45° field of view · CFP.
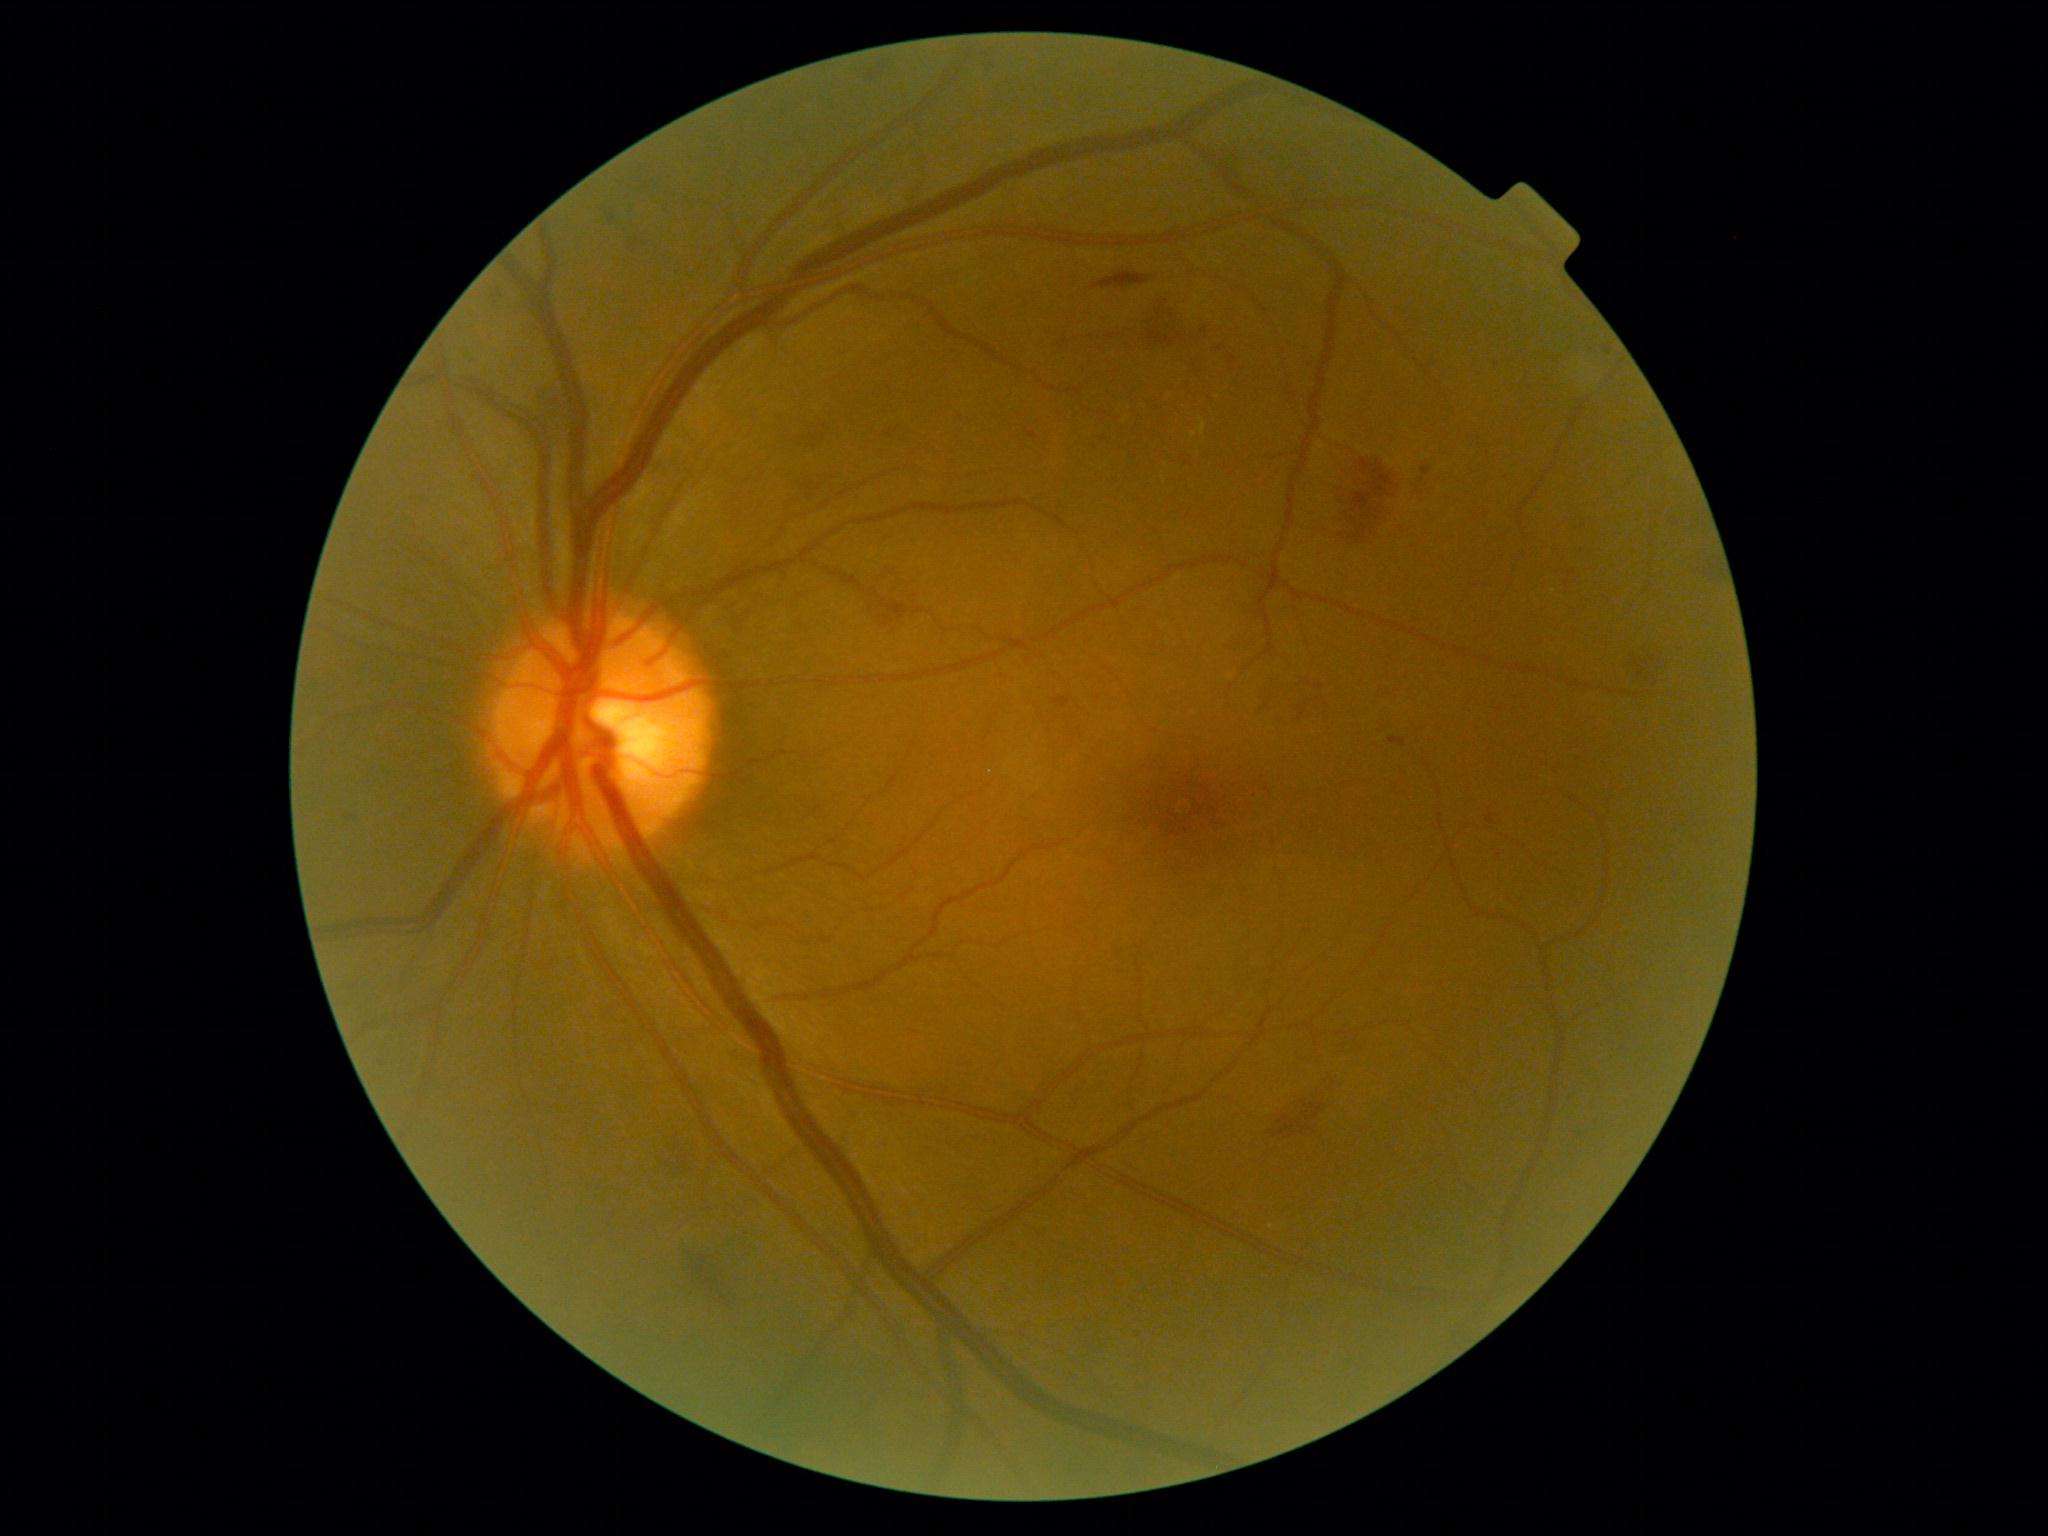 <lesions partial="true">
  <dr_grade>2</dr_grade>
  <se />
  <ex>x1=1200, y1=418, x2=1207, y2=435</ex>
  <ex_small>1194, 435</ex_small>
  <ma>x1=1216, y1=346, x2=1224, y2=352; x1=980, y1=57, x2=989, y2=65; x1=346, y1=816, x2=354, y2=822; x1=1026, y1=429, x2=1039, y2=441; x1=1388, y1=738, x2=1407, y2=748; x1=1605, y1=346, x2=1613, y2=356; x1=1315, y1=684, x2=1325, y2=691; x1=1486, y1=810, x2=1497, y2=826; x1=1201, y1=327, x2=1208, y2=336; x1=1053, y1=698, x2=1070, y2=708; x1=1420, y1=467, x2=1432, y2=483; x1=1569, y1=570, x2=1577, y2=578</ma>
  <ma_small>1497, 365; 1585, 526; 1140, 1336</ma_small>
  <he partial="true">x1=1297, y1=700, x2=1310, y2=721; x1=868, y1=62, x2=888, y2=82; x1=1417, y1=481, x2=1438, y2=500; x1=796, y1=483, x2=832, y2=503; x1=538, y1=386, x2=575, y2=450; x1=1065, y1=293, x2=1213, y2=386; x1=683, y1=1247, x2=742, y2=1317; x1=490, y1=284, x2=509, y2=307; x1=1624, y1=652, x2=1668, y2=681; x1=666, y1=1146, x2=691, y2=1181; x1=733, y1=616, x2=746, y2=631; x1=887, y1=424, x2=915, y2=445</he>
  <he_small>1265, 708</he_small>
</lesions>